Modified Davis classification:
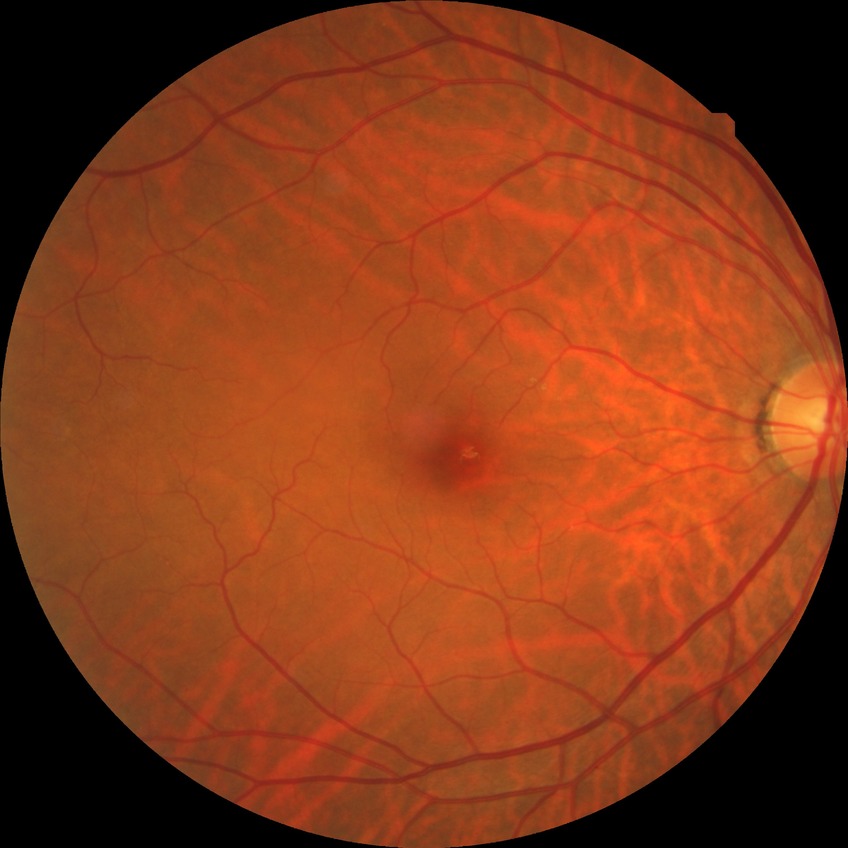 No DR findings. Davis stage: NDR.